2212 by 1659 pixels:
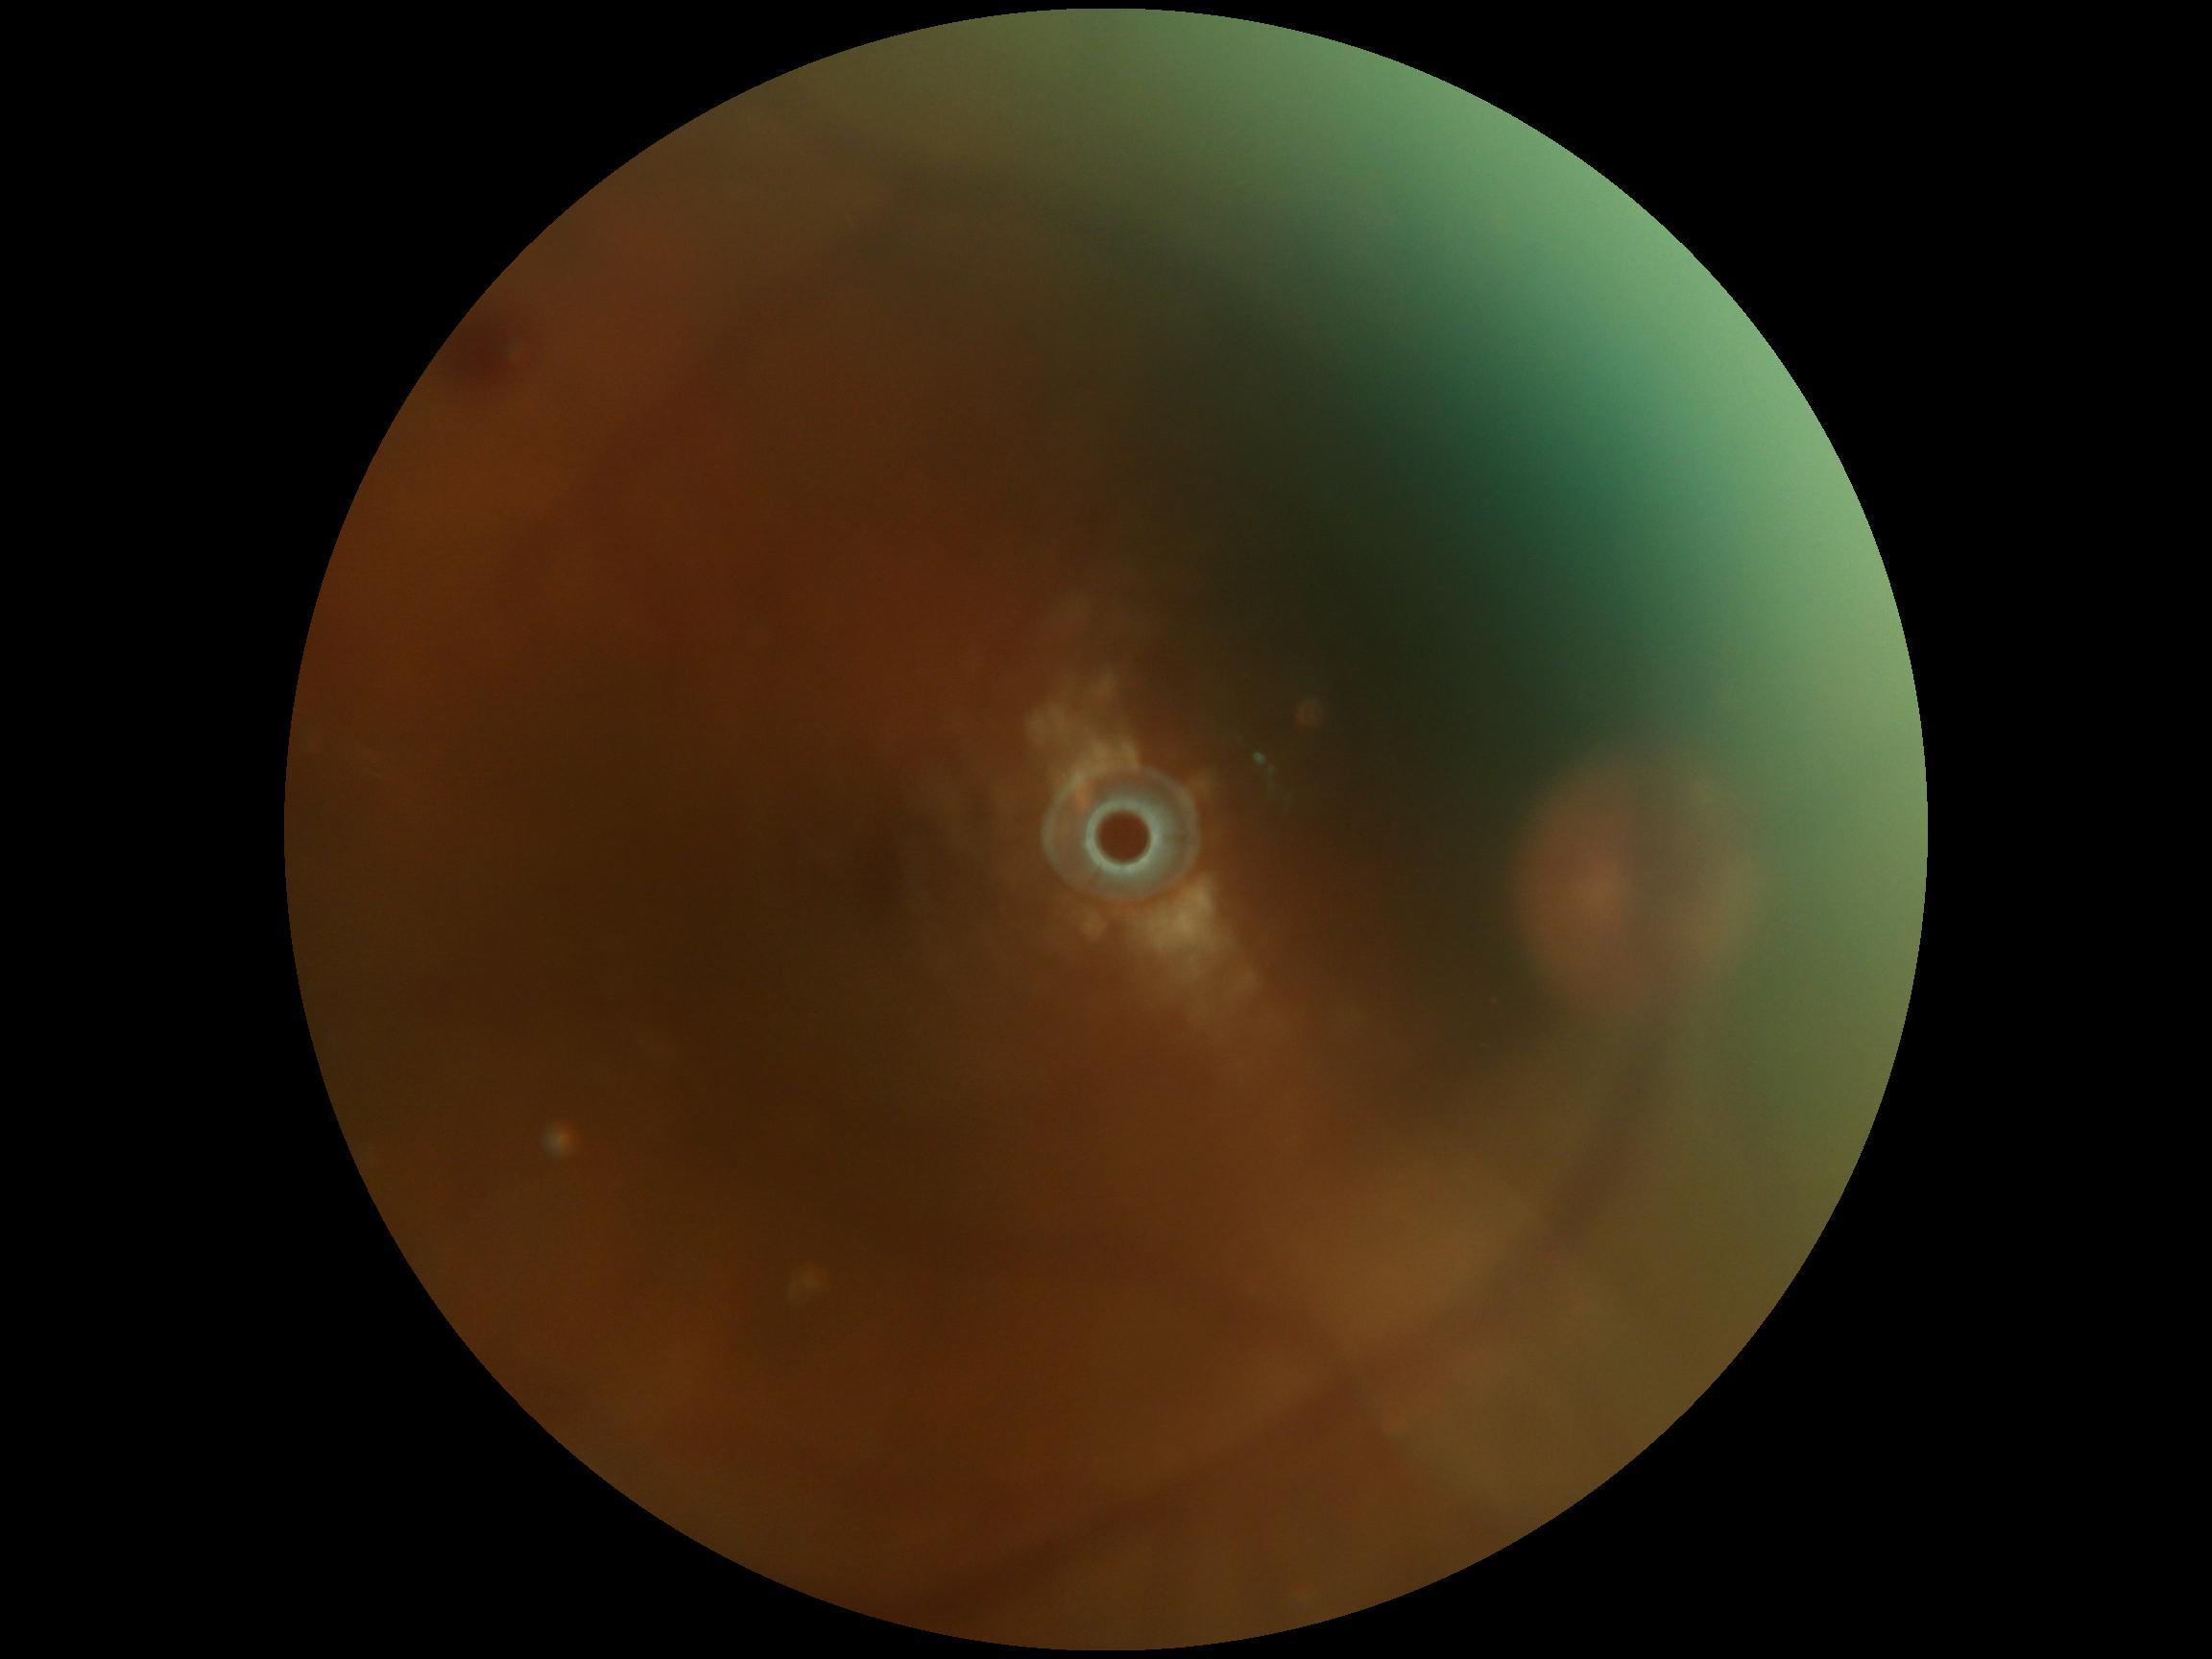
{"dr_grade": "2", "dr_category": "non-proliferative diabetic retinopathy"}